Color fundus image
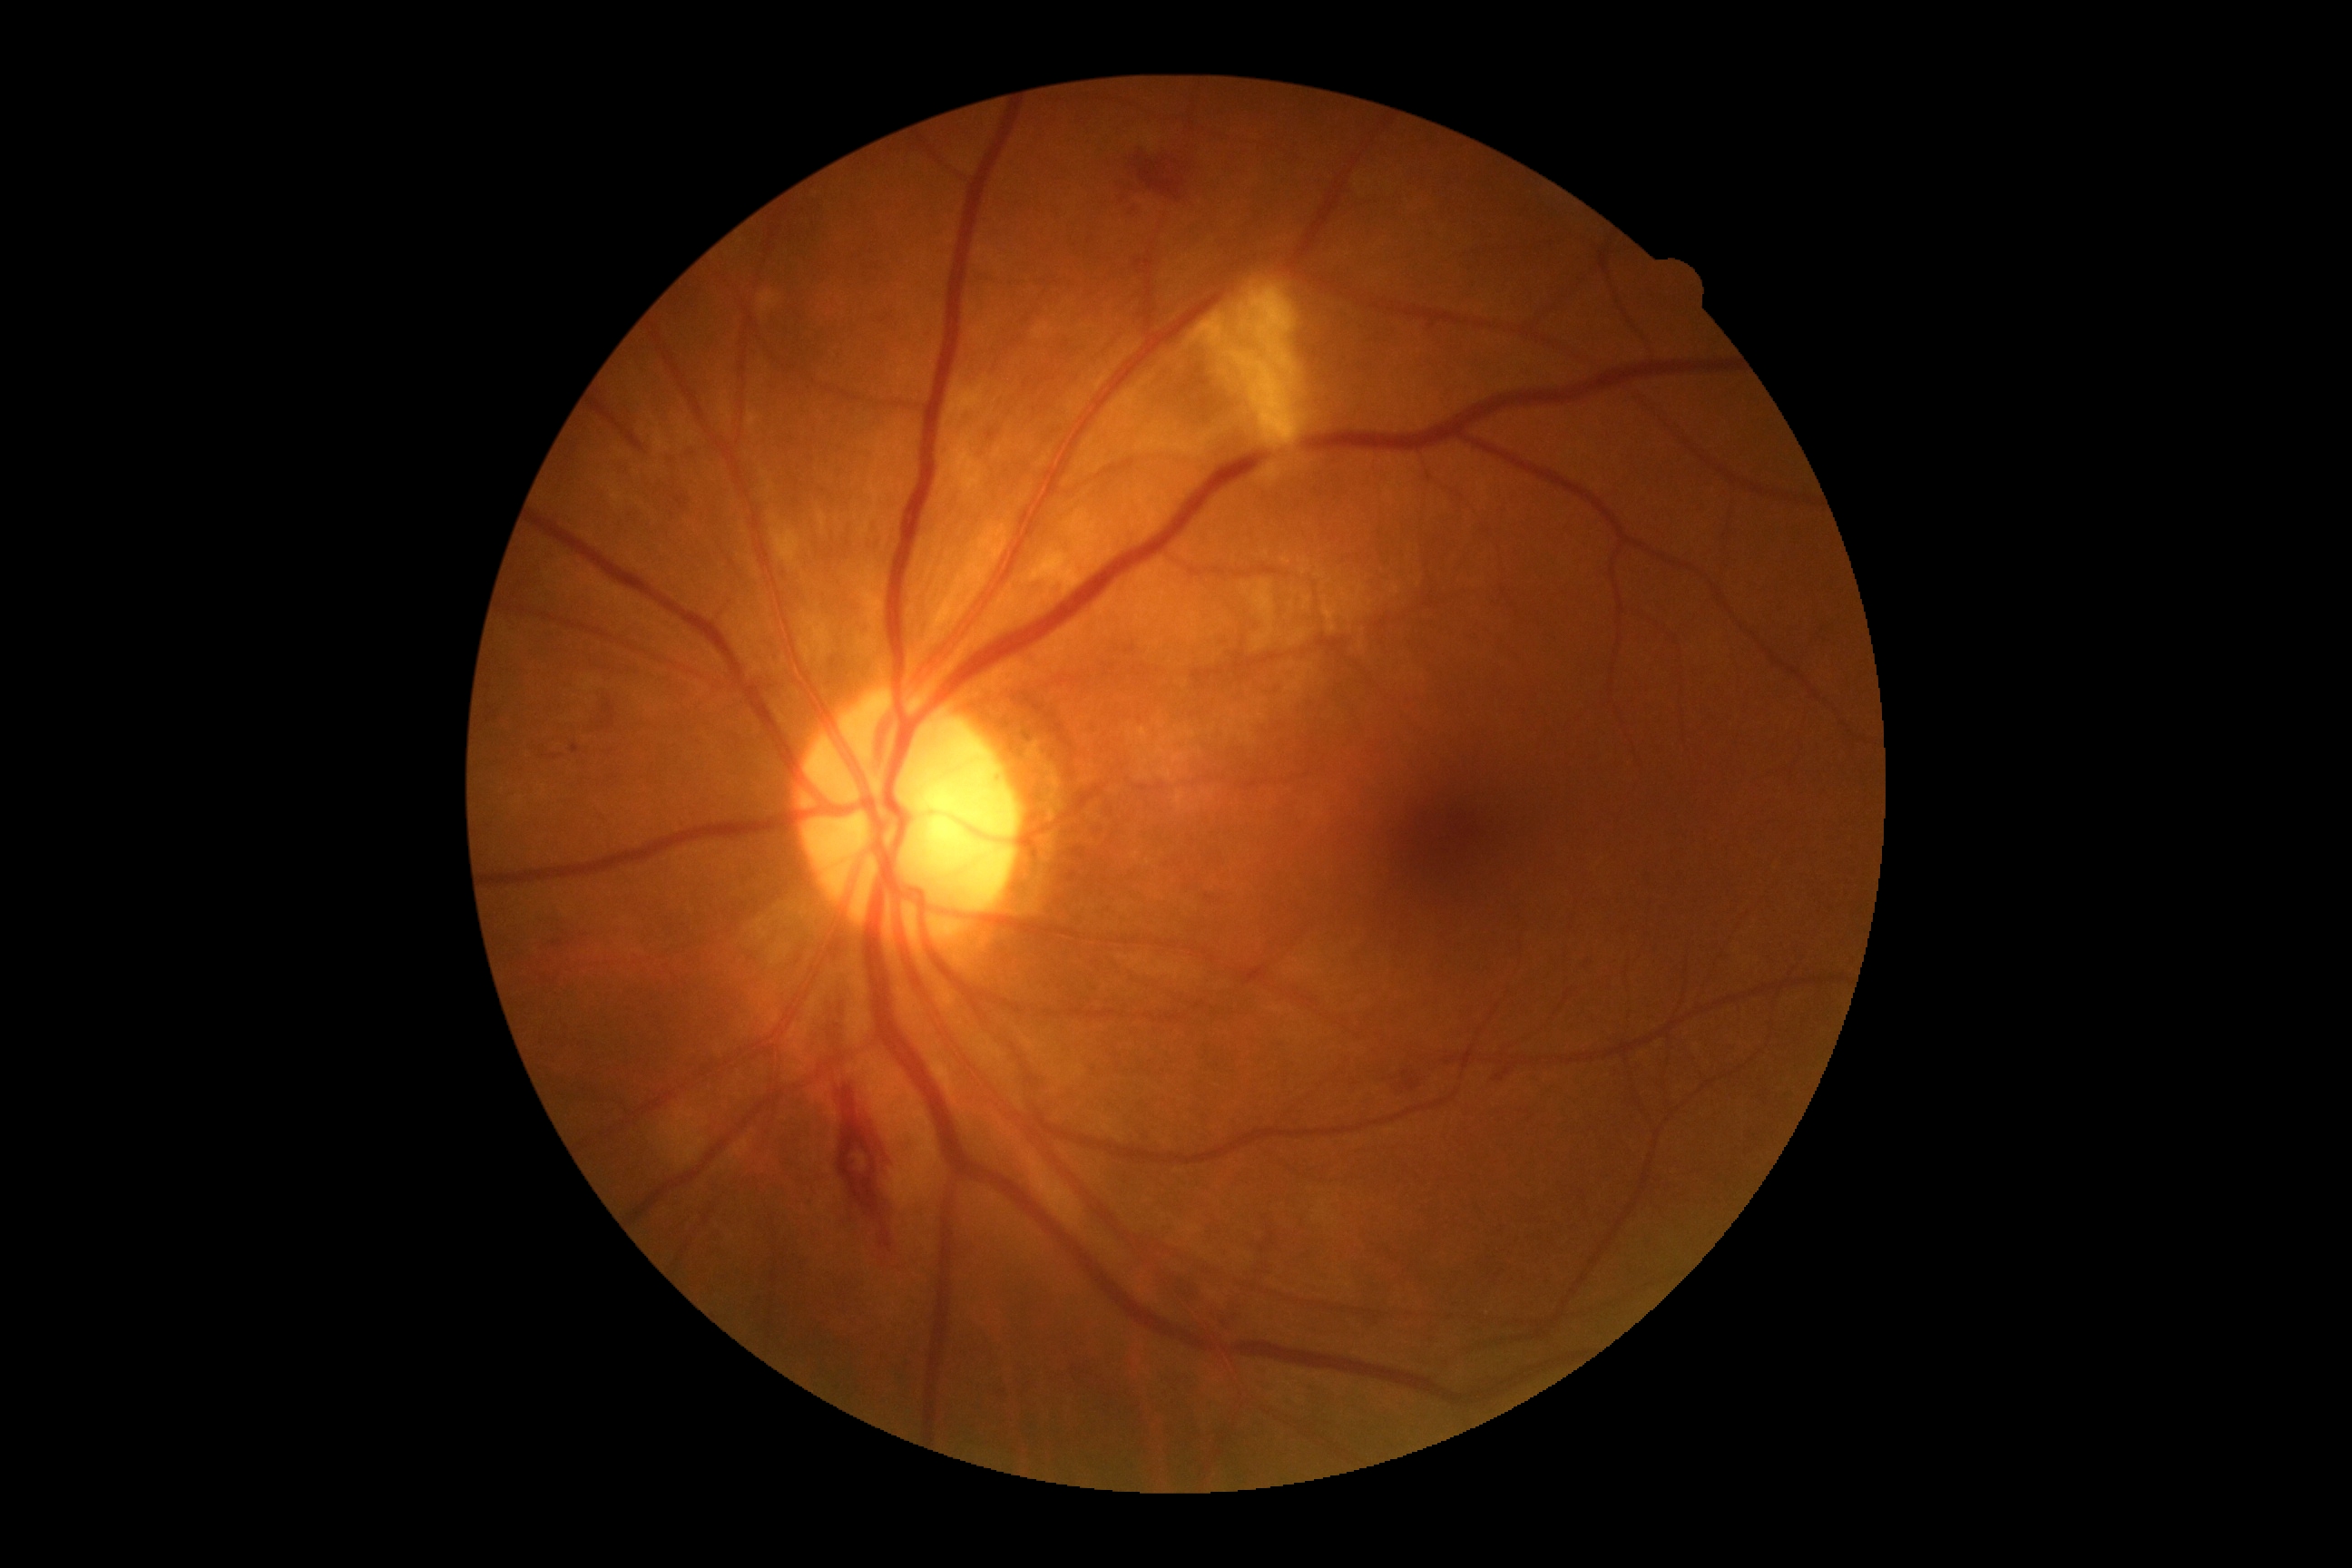
DR class = non-proliferative diabetic retinopathy; retinopathy = 2/4 — more than just microaneurysms but less than severe NPDR.